45° field of view. Fundus photo: 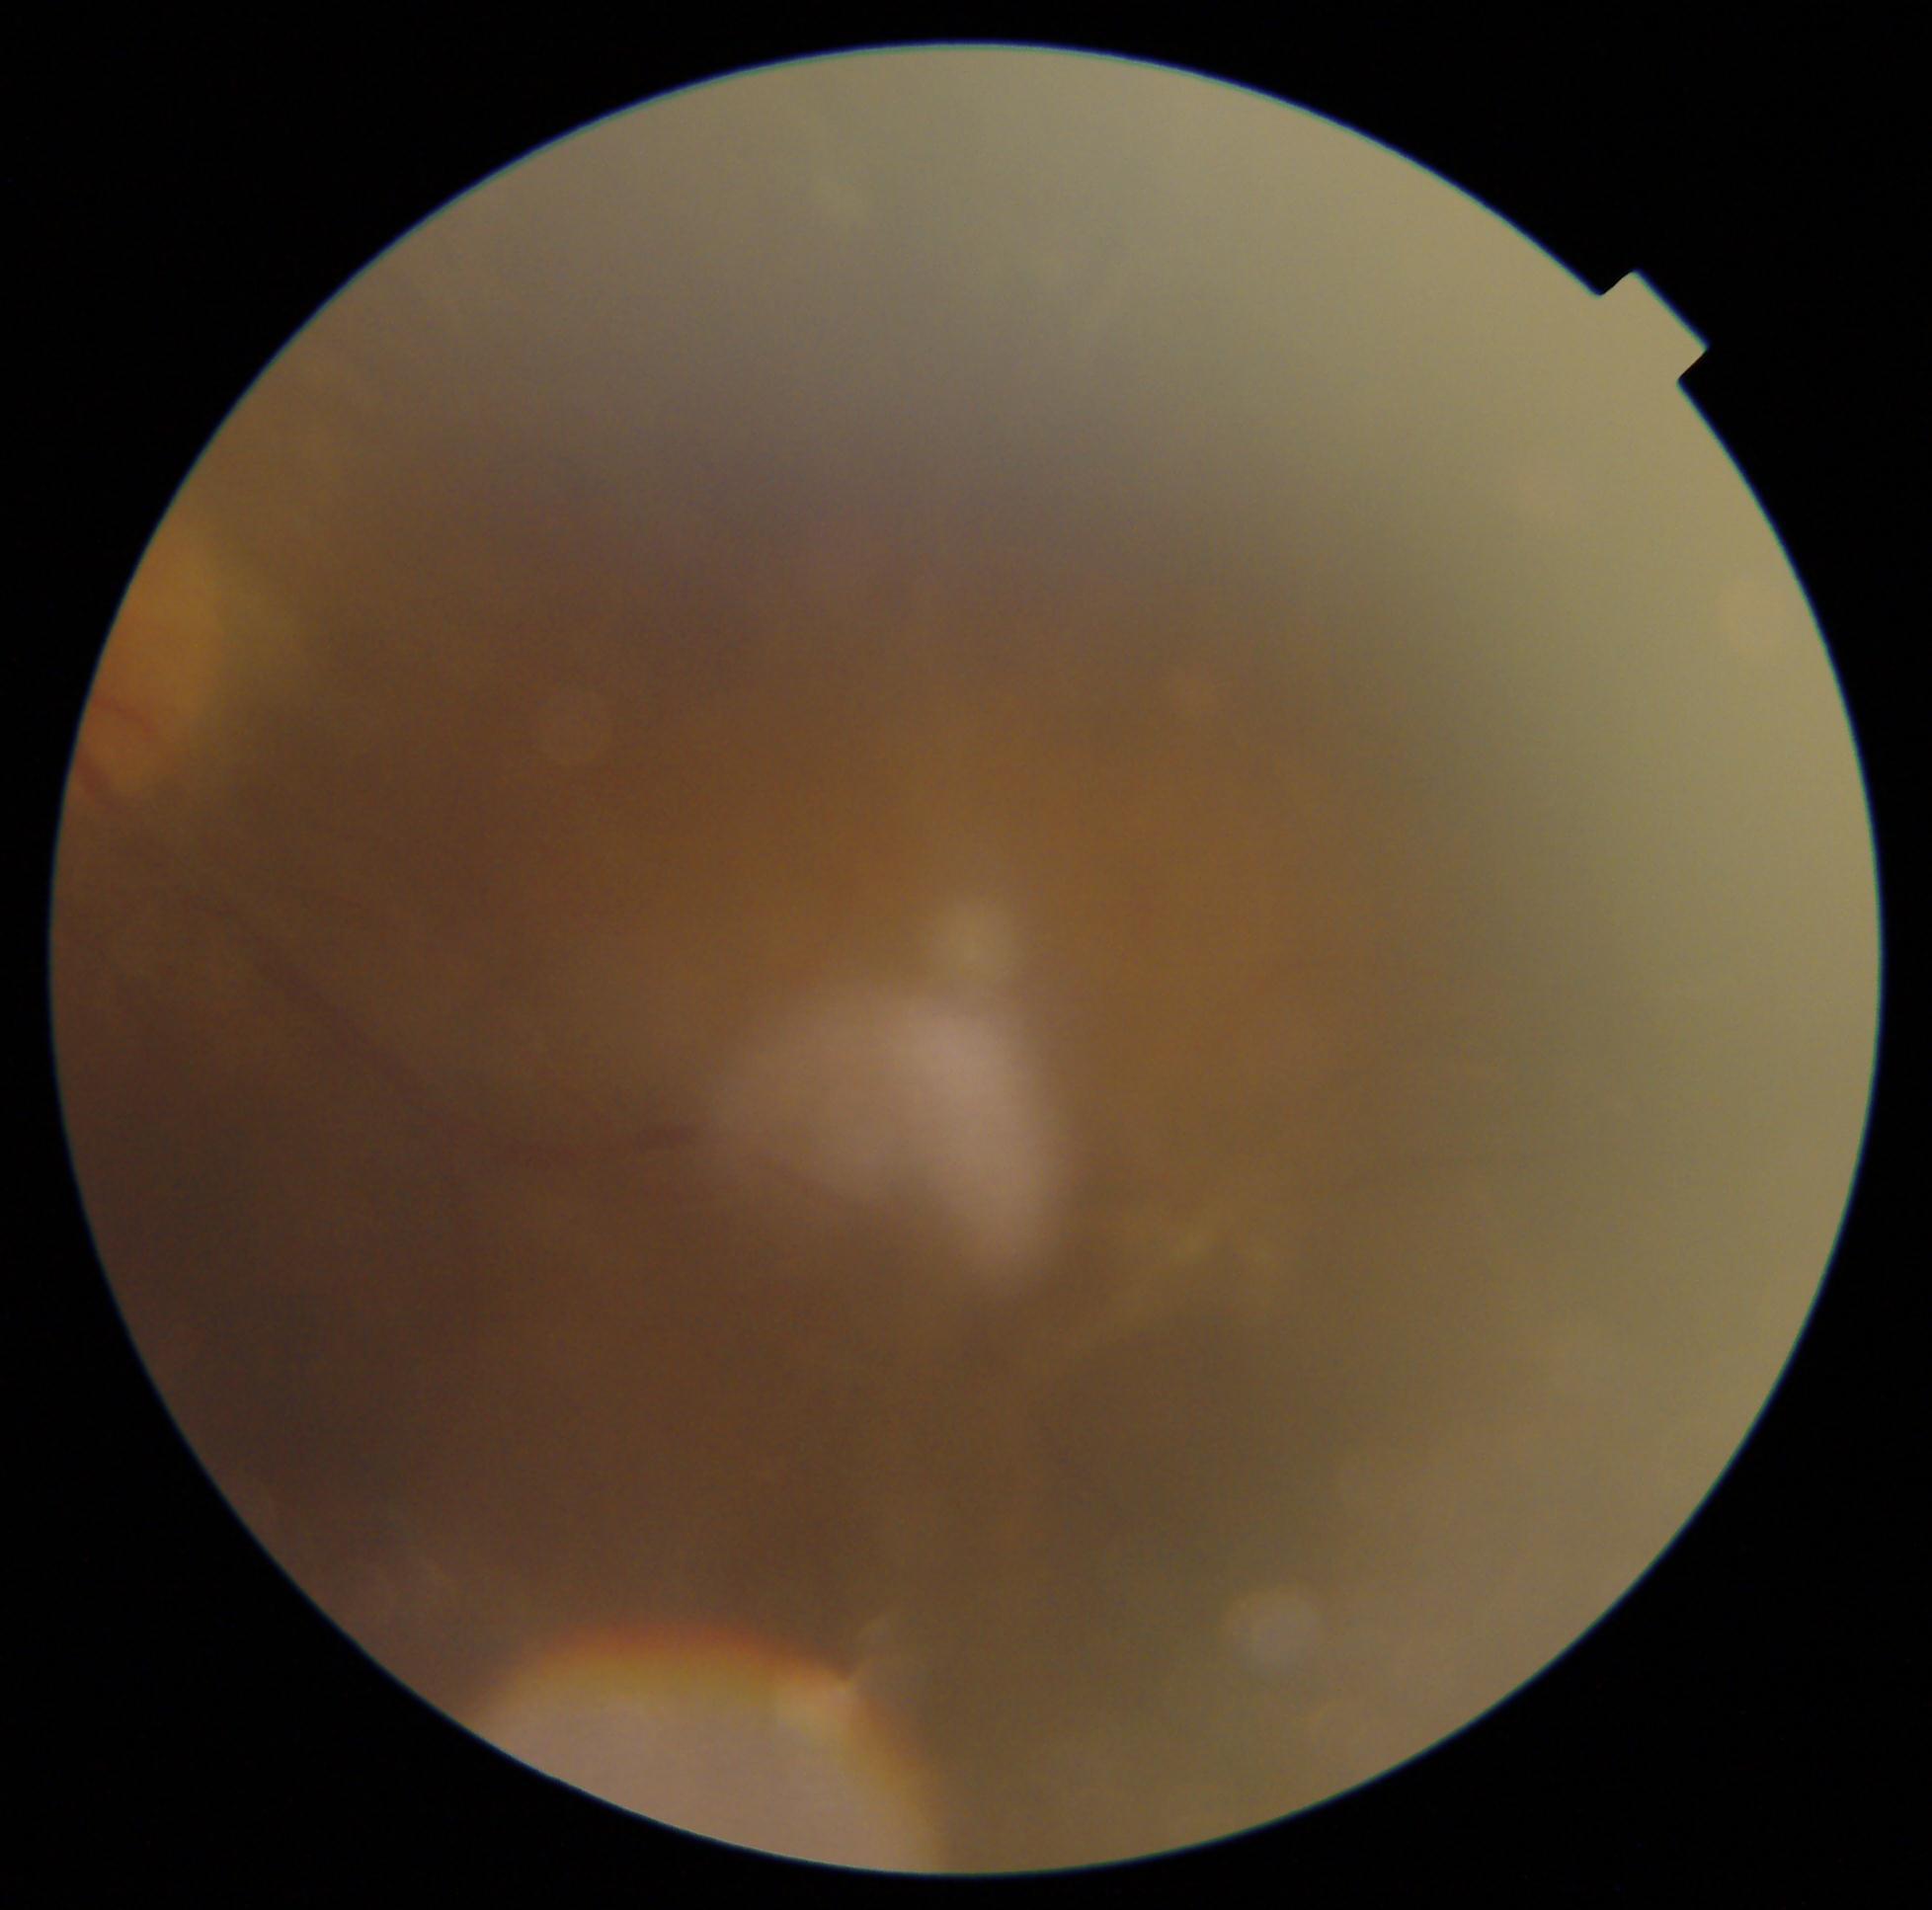 DR severity@ungradable due to poor image quality.